Pediatric retinal photograph (wide-field).
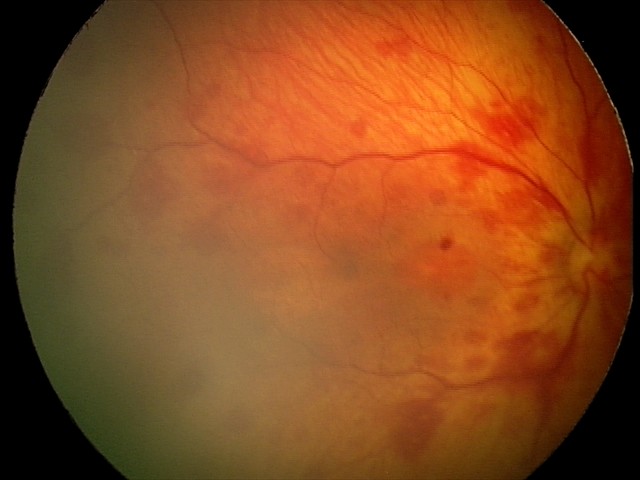

From an examination with diagnosis of retinal hemorrhages.